Retinal fundus photograph — 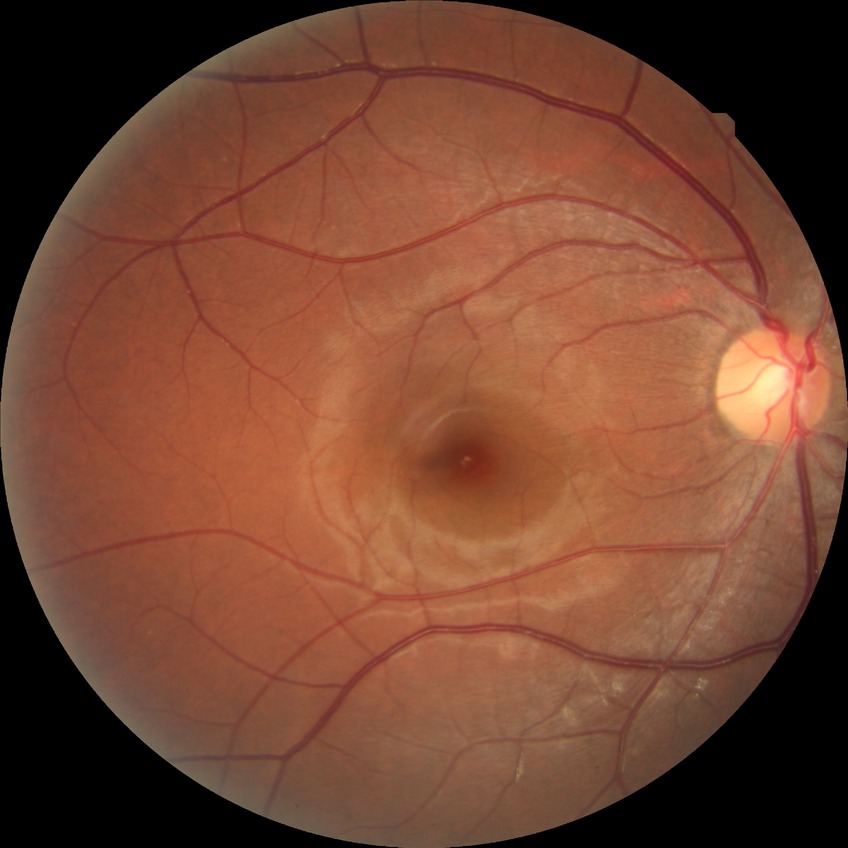 diabetic retinopathy (DR)=NDR (no diabetic retinopathy).